DR severity per modified Davis staging
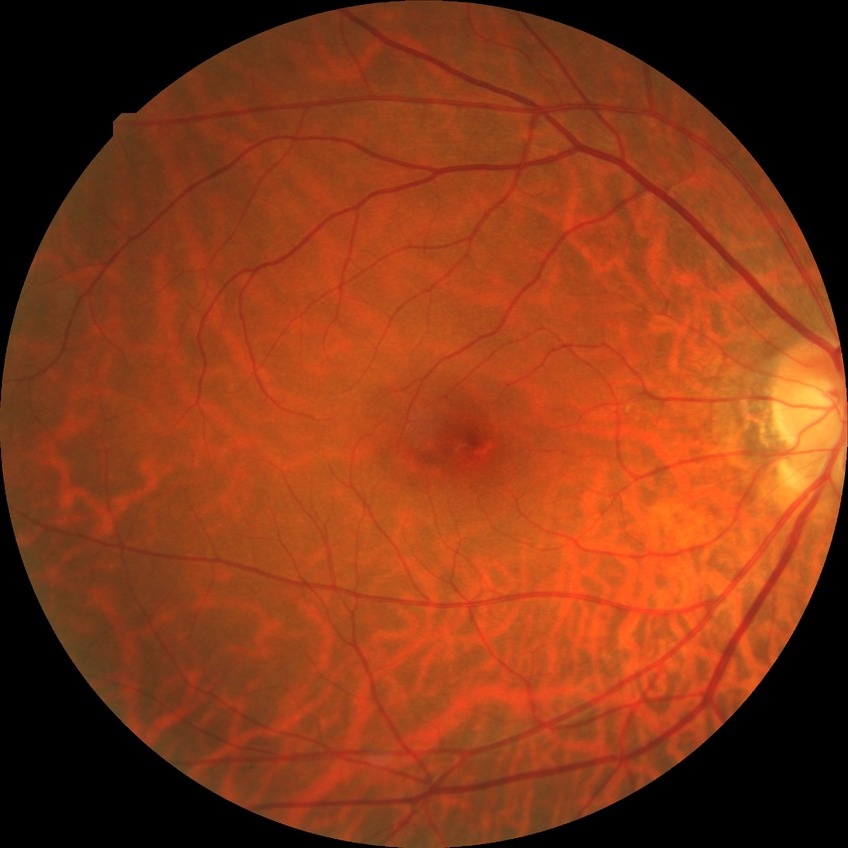
DR impression = no apparent DR; Davis grade = NDR.